45-degree field of view · acquired with a NIDEK AFC-230 · 848 by 848 pixels:
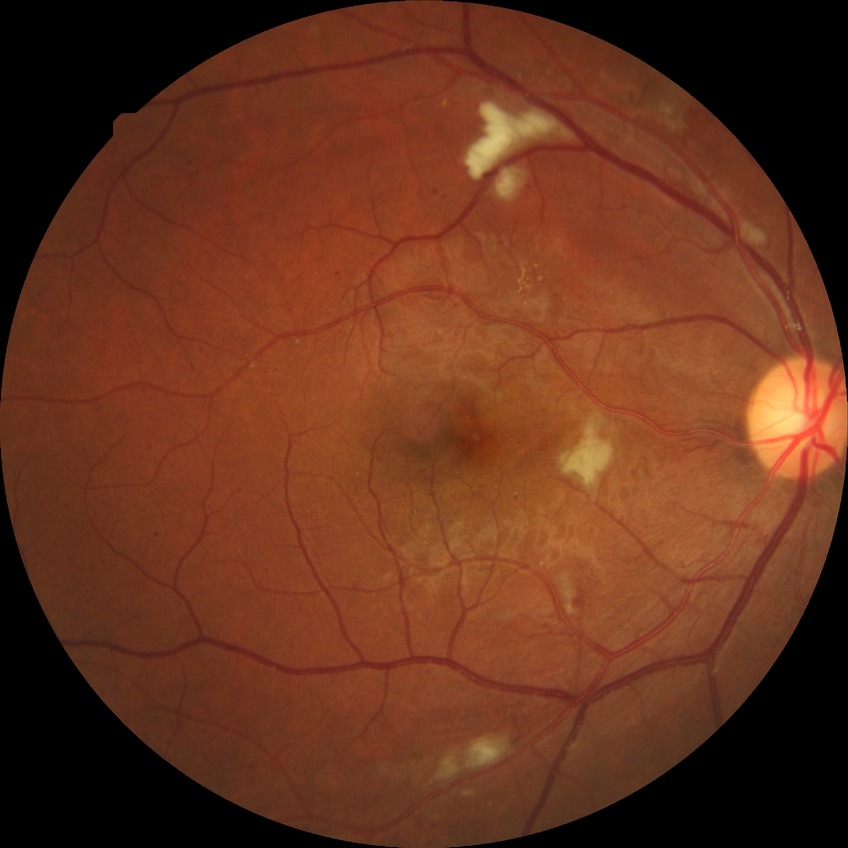
DR stage is PPDR.